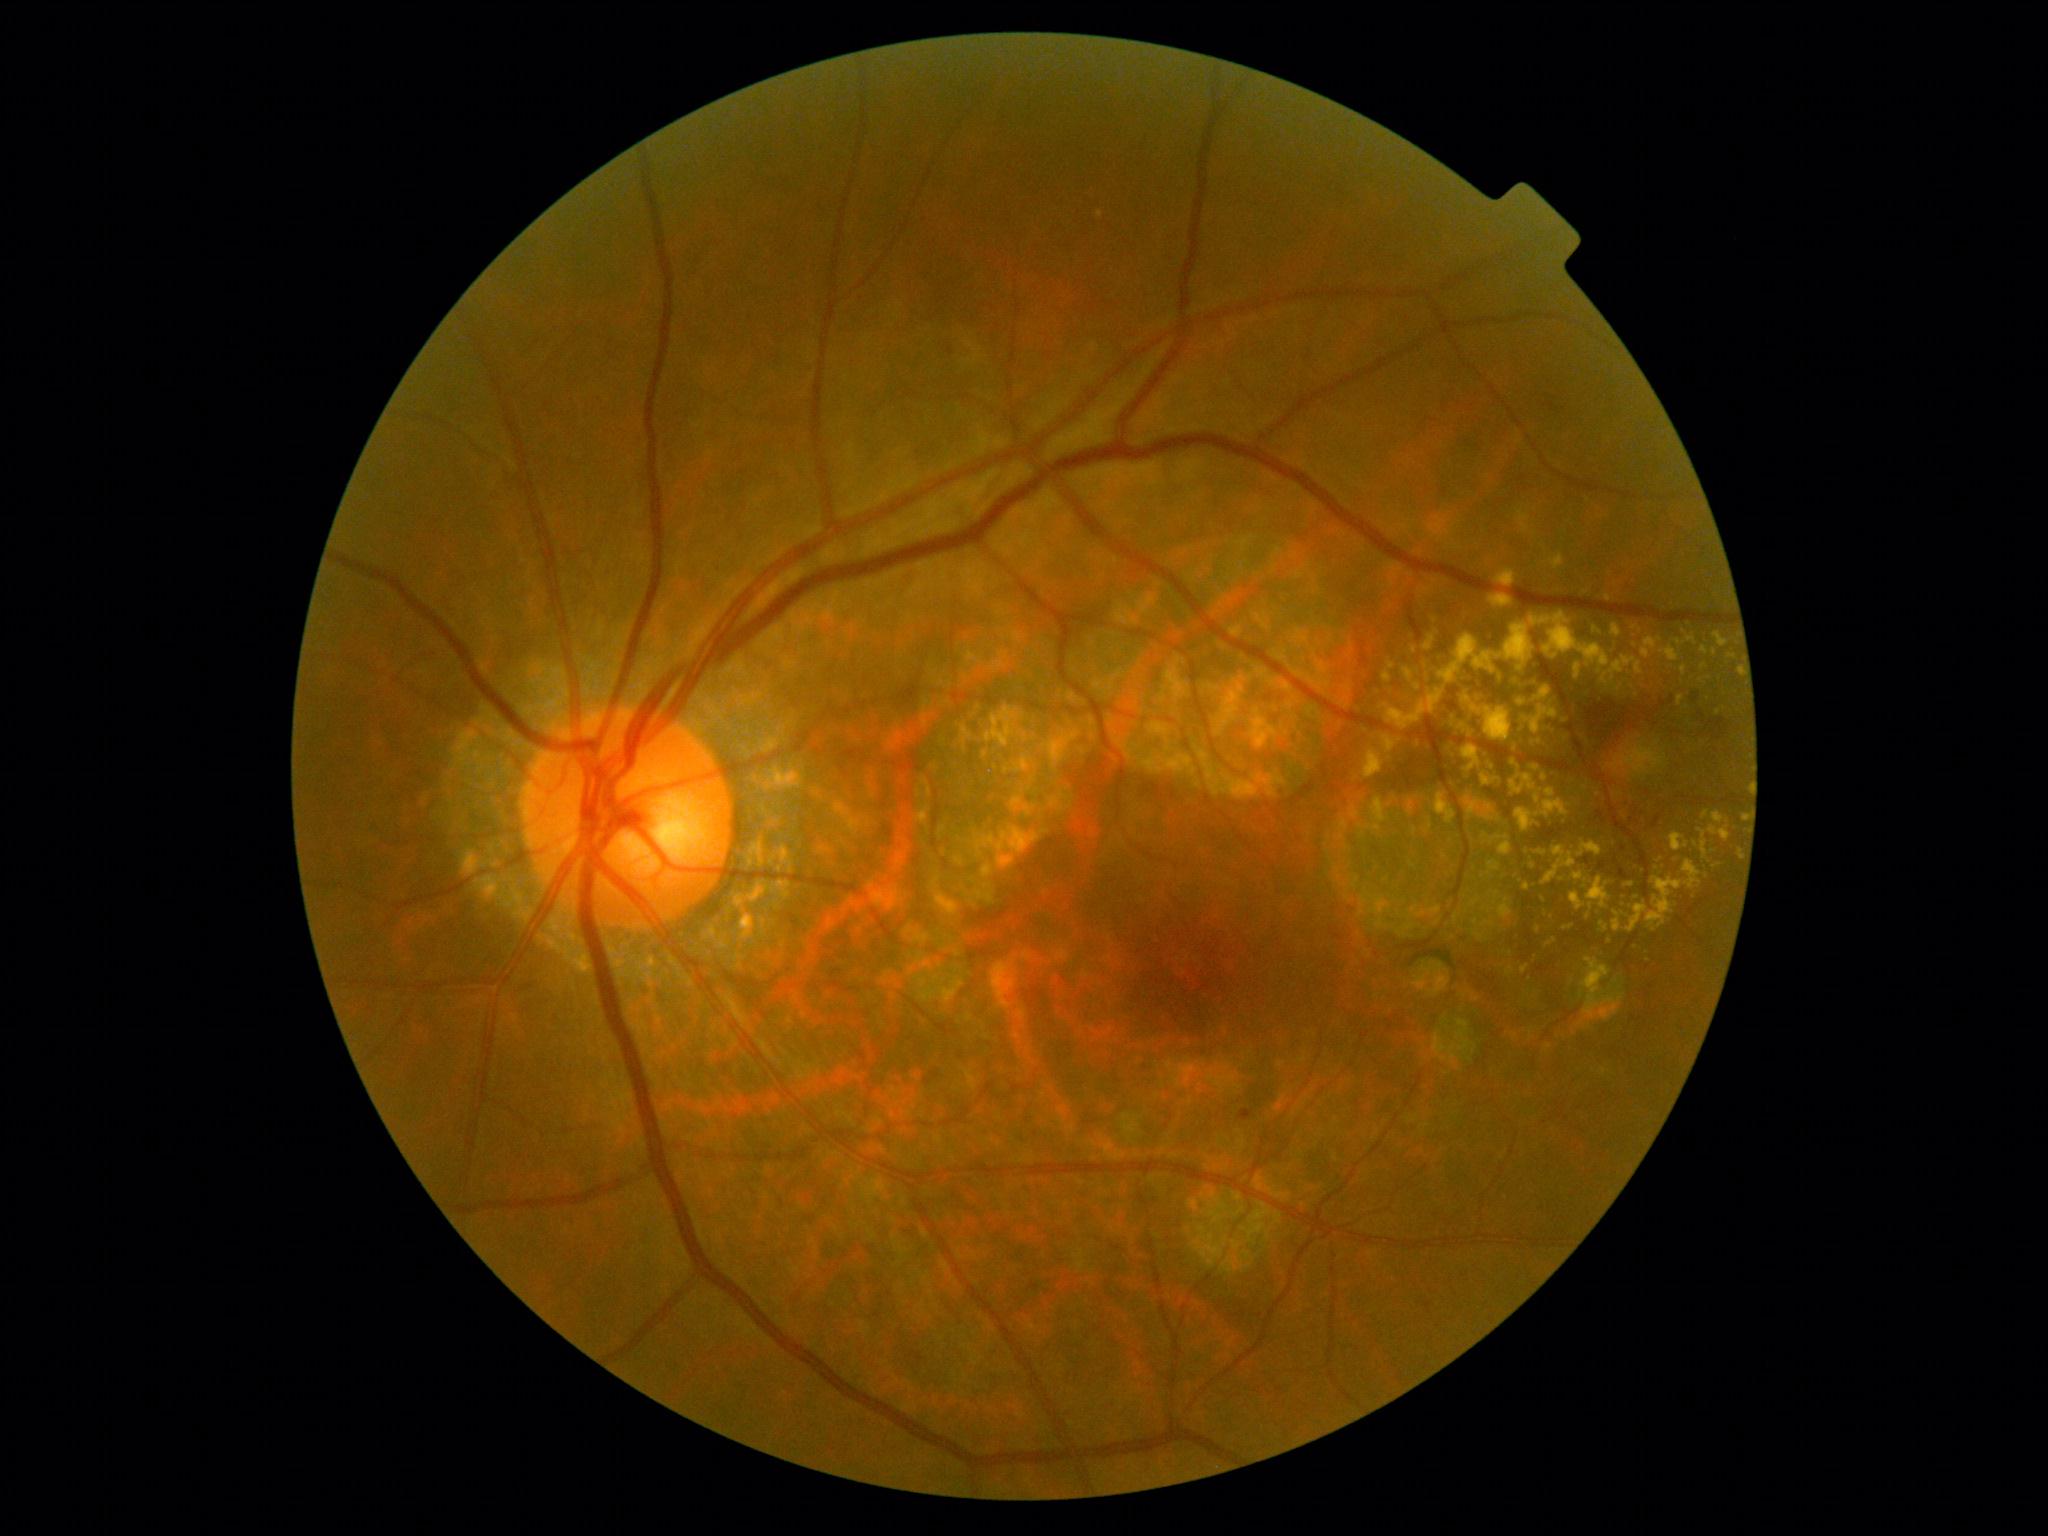 DR grade: 2
Lesions identified (partial list):
* EXs (continued): rect(1571, 892, 1586, 911) | rect(1450, 736, 1482, 773) | rect(1599, 922, 1609, 933) | rect(1423, 633, 1437, 651) | rect(1510, 760, 1571, 833) | rect(1495, 569, 1516, 588) | rect(1594, 627, 1602, 636) | rect(1523, 884, 1530, 892) | rect(1698, 829, 1708, 861) | rect(1641, 638, 1662, 660) | rect(1531, 766, 1541, 772) | rect(1463, 687, 1477, 699)
* Additional small EXs near <pt>1618,691</pt> | <pt>1544,900</pt> | <pt>1414,650</pt> | <pt>1625,915</pt> | <pt>1565,721</pt> | <pt>1588,917</pt> | <pt>1676,860</pt>